Image size 2352x1568:
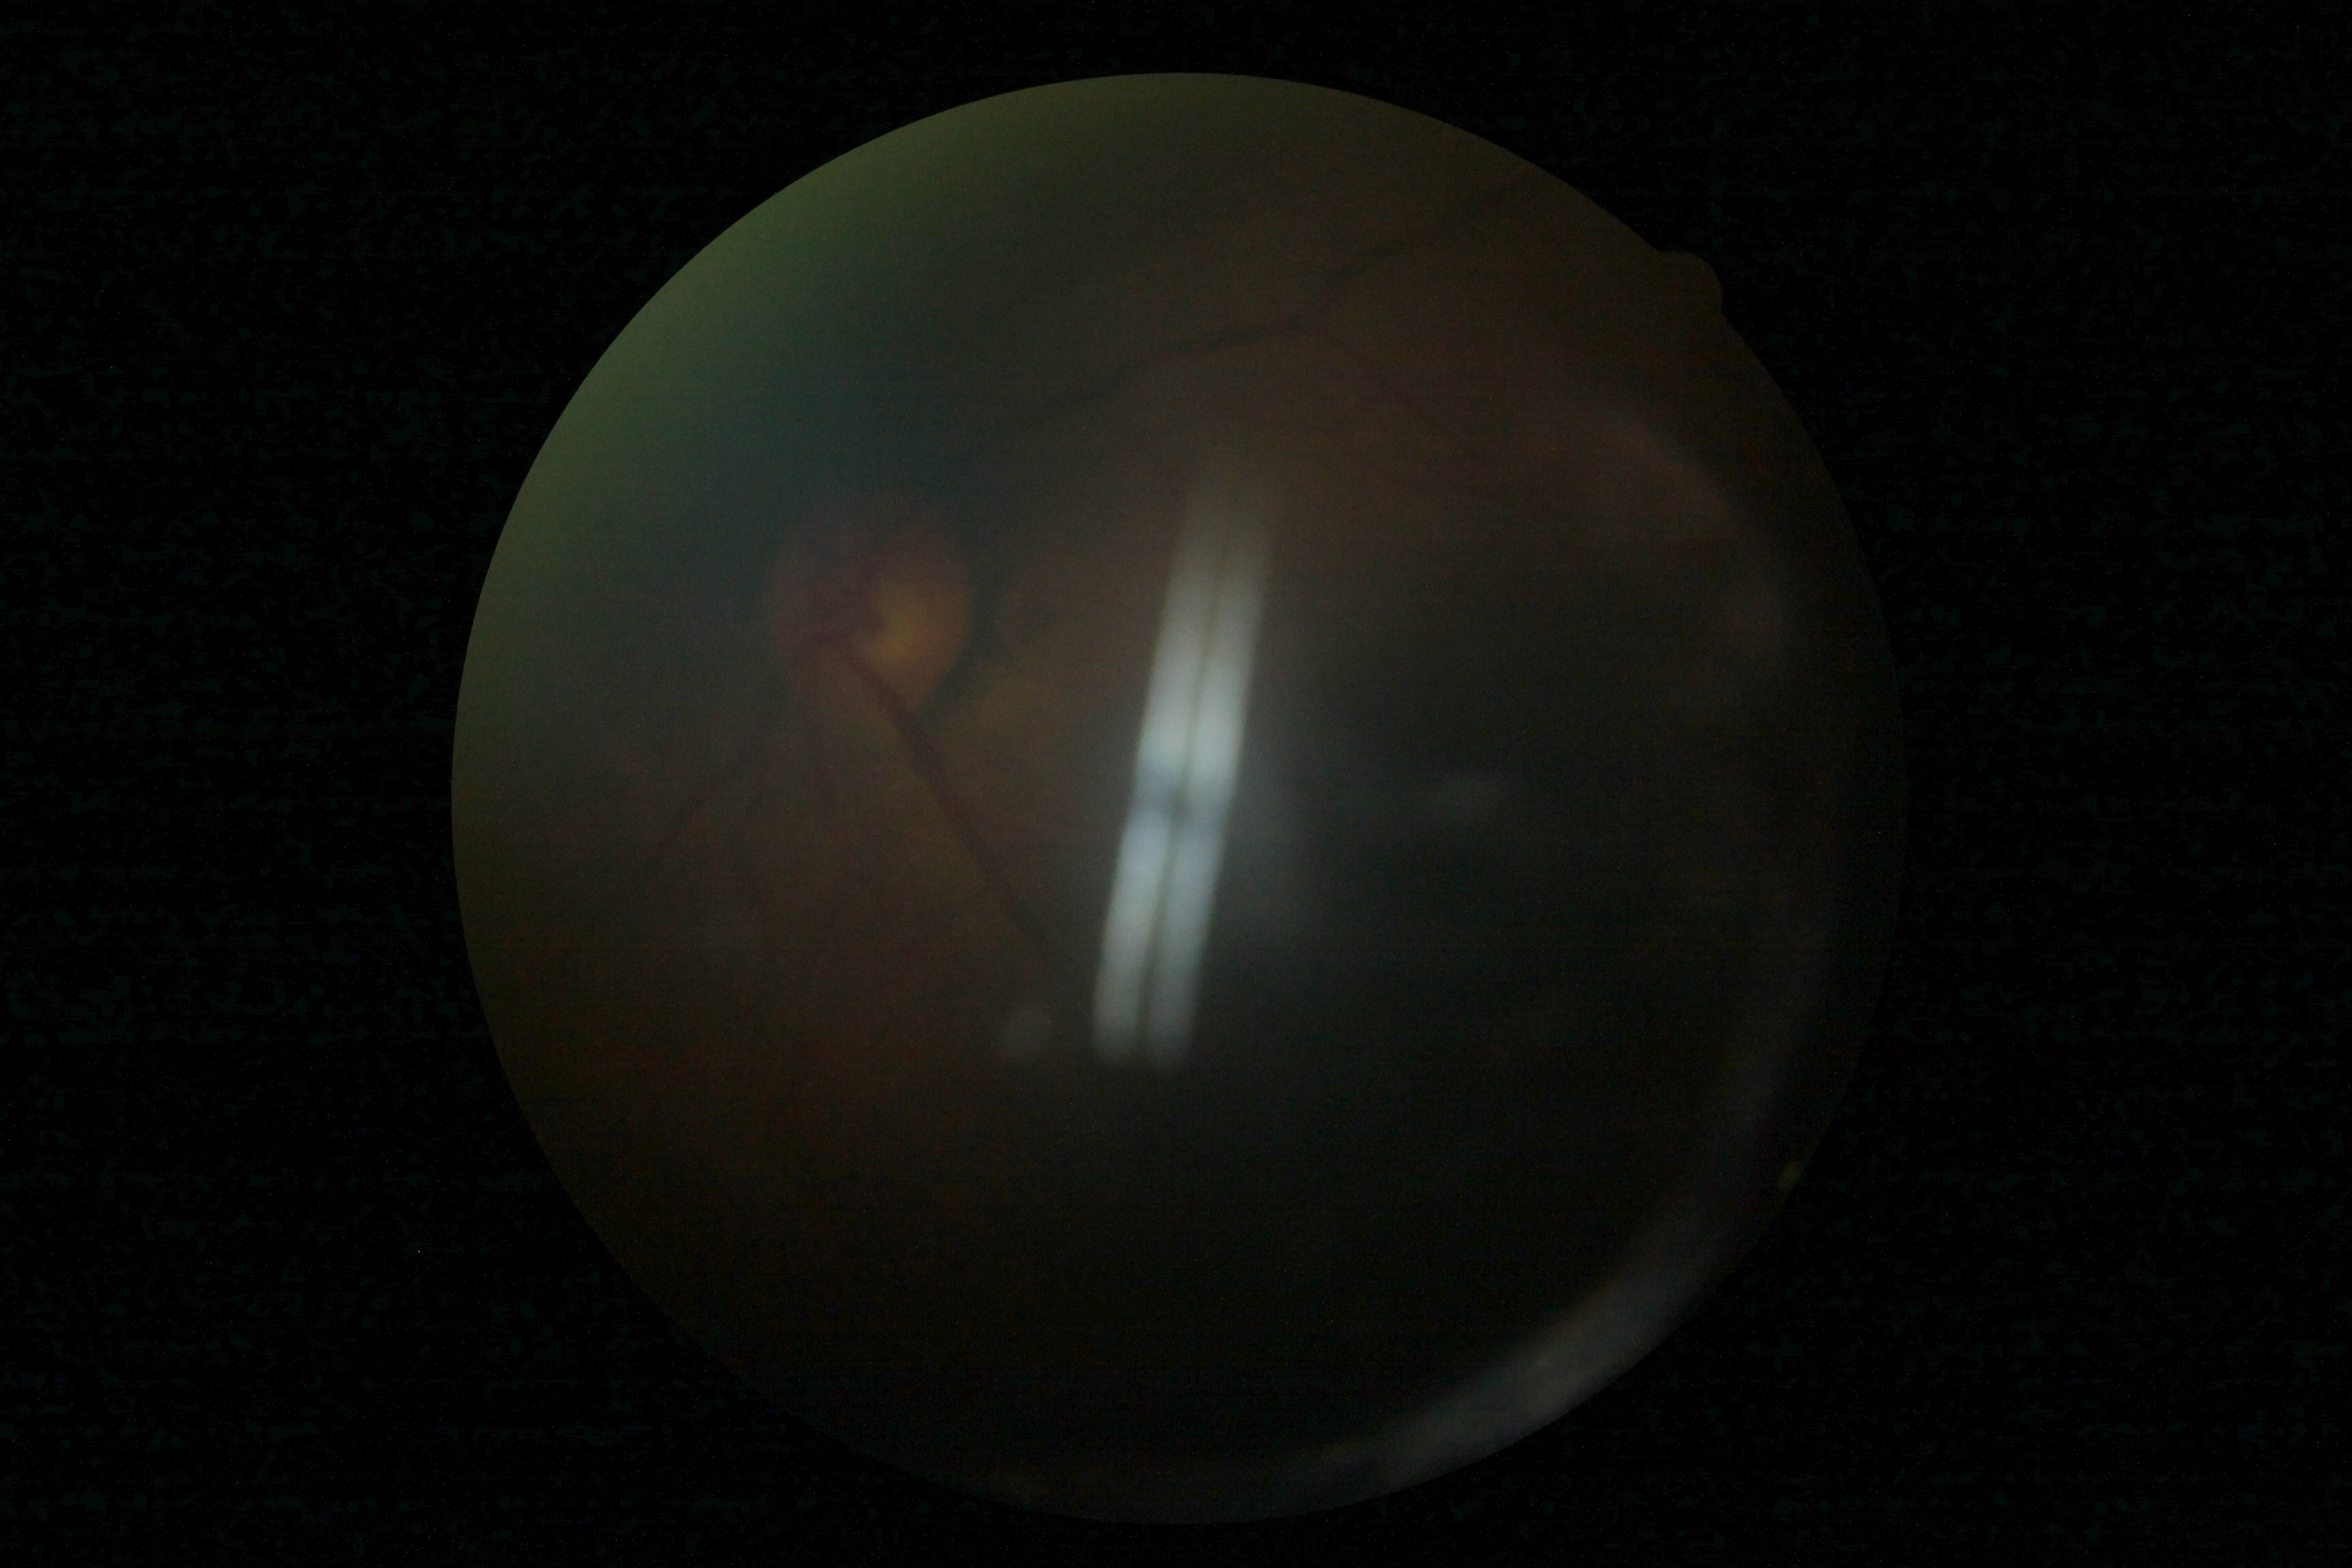 Quality too poor to assess for DR. Retinopathy grade is ungradable.